Acquired on the Clarity RetCam 3; pediatric wide-field fundus photograph
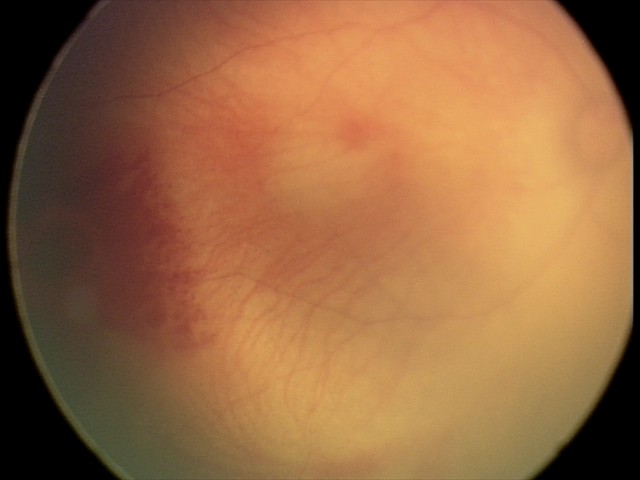
Diagnosis from this screening exam: retinal hemorrhages.